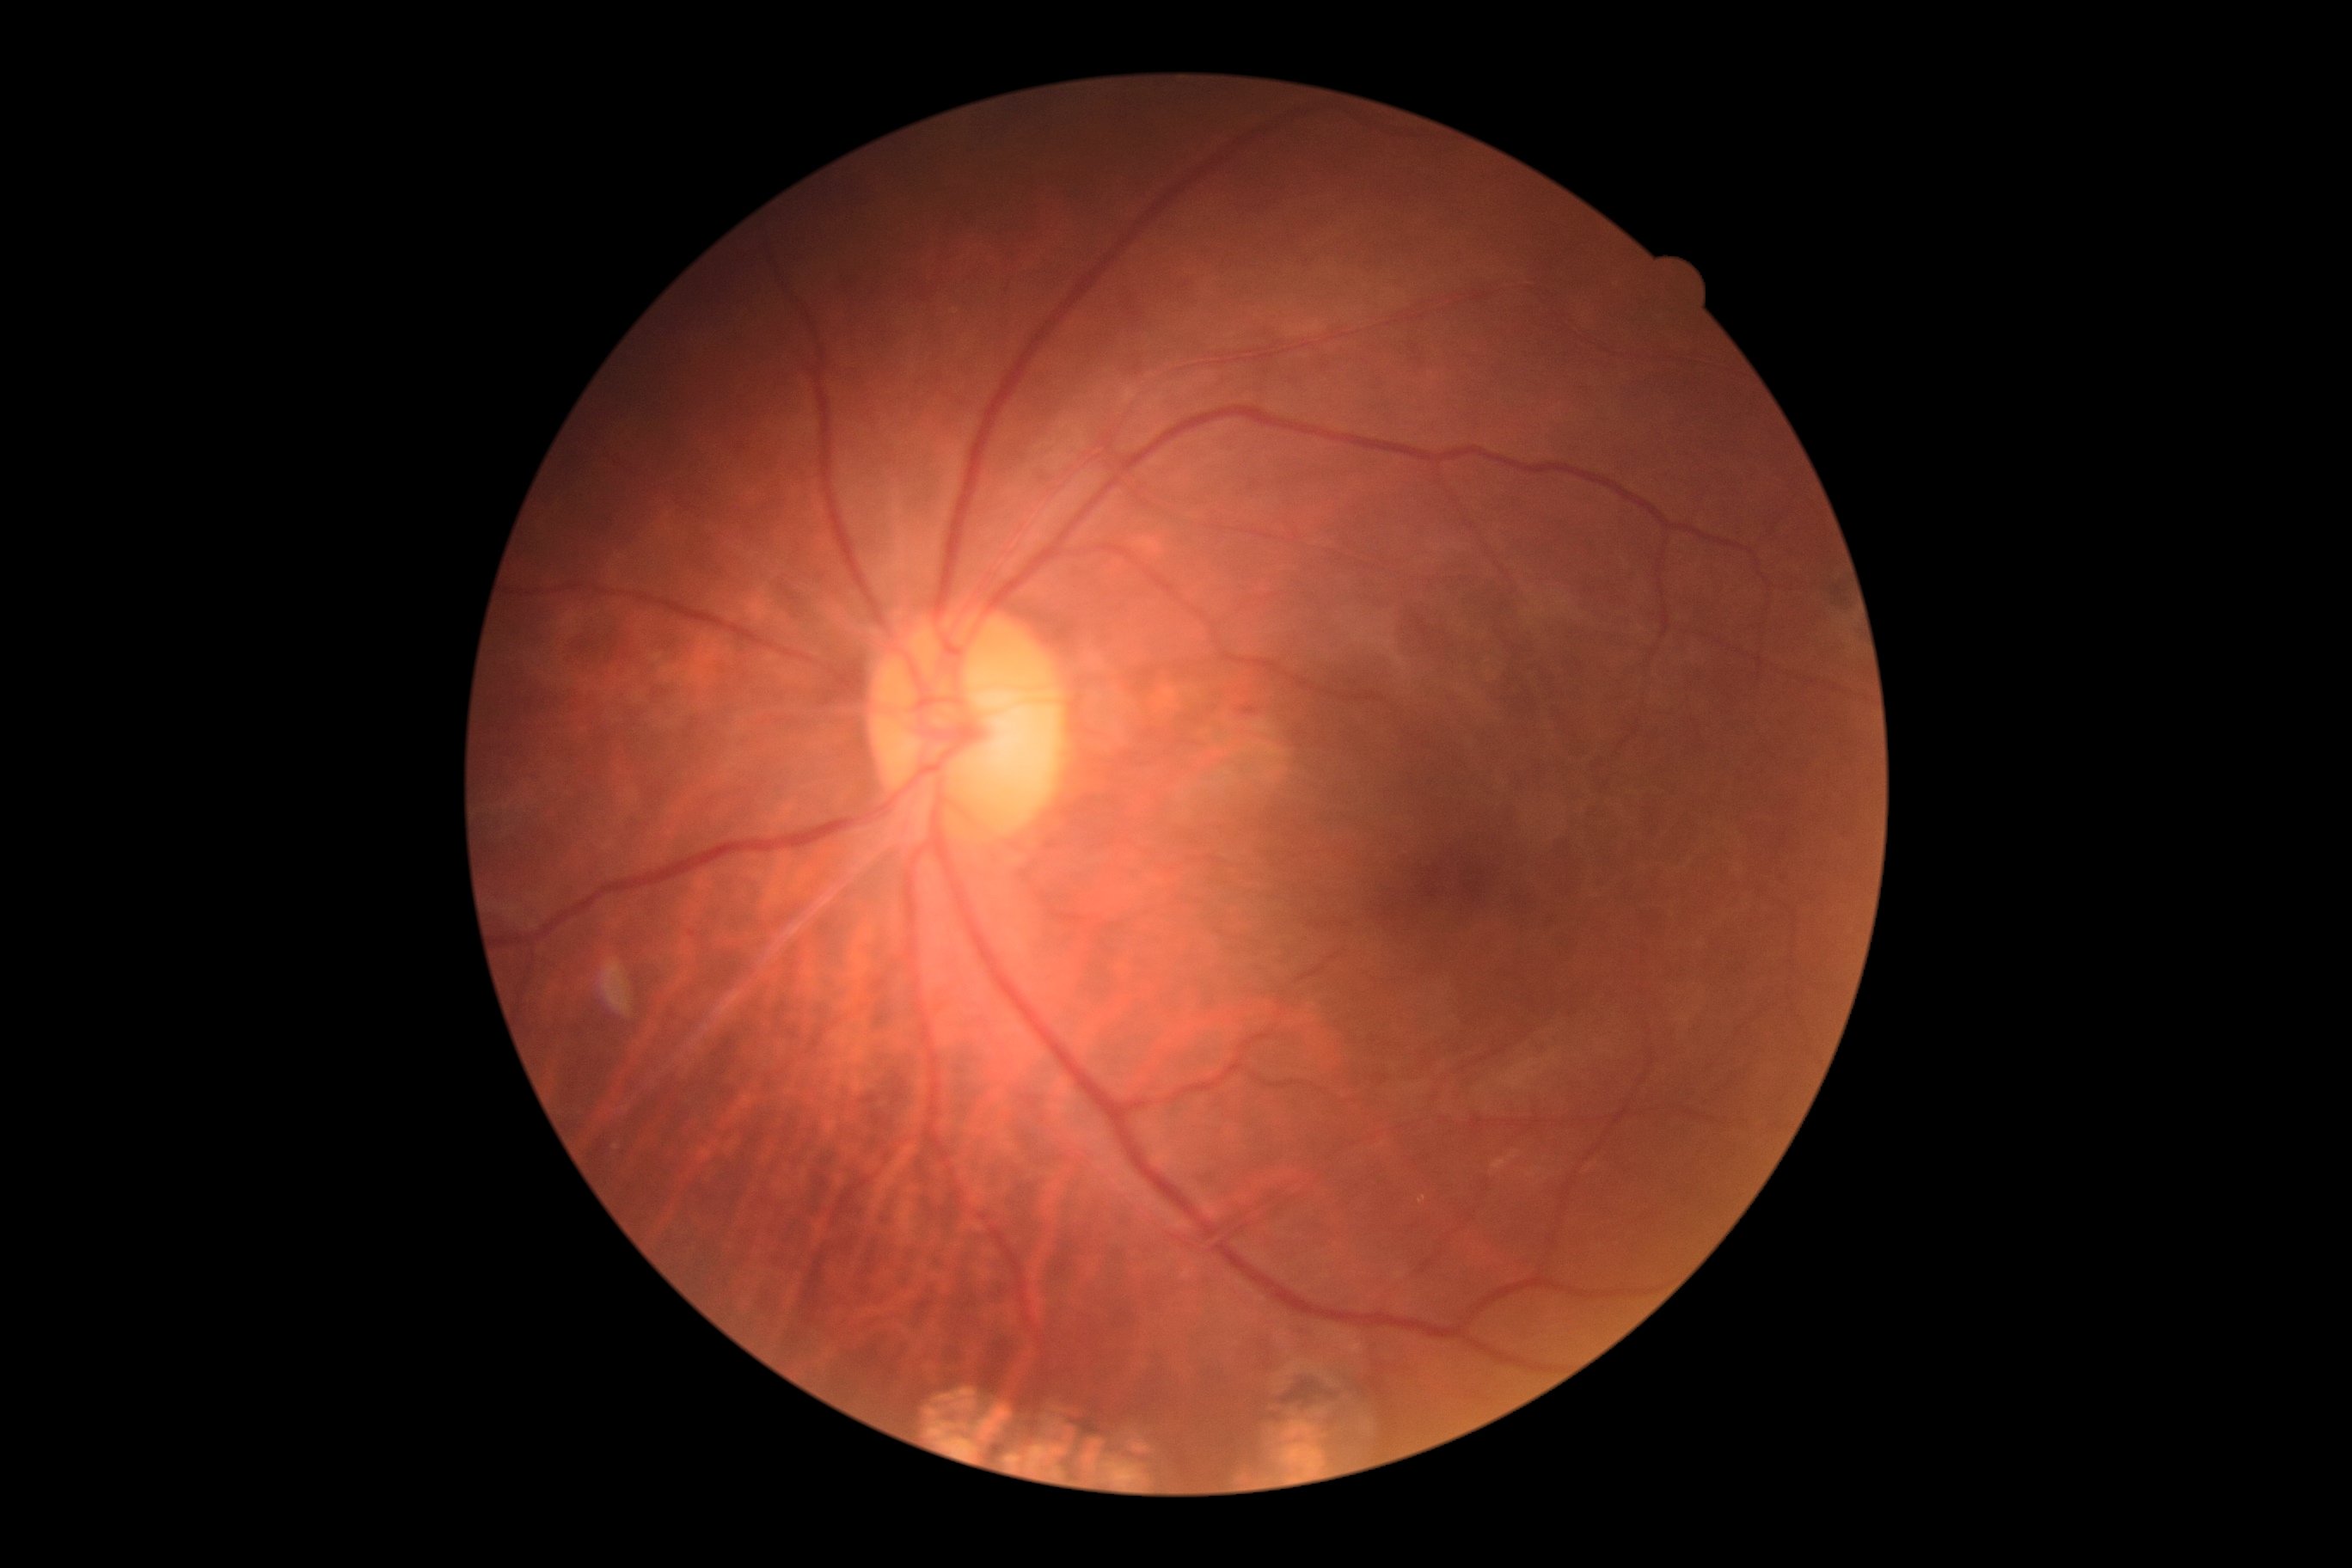

{
  "dr_grade": "1/4"
}